No pharmacologic dilation · acquired with a NIDEK AFC-230 · fundus photo:
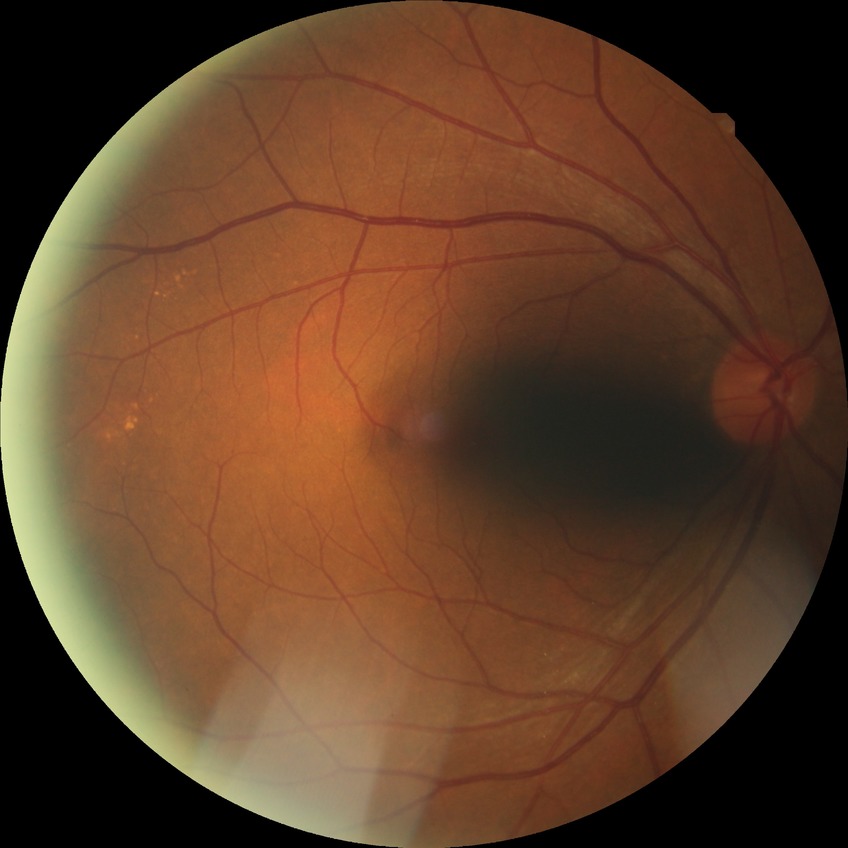 Diabetic retinopathy (DR): no diabetic retinopathy (NDR).